Phoenix ICON wide-field infant fundus image. Camera: Phoenix ICON (100° FOV). 1240x1240px: 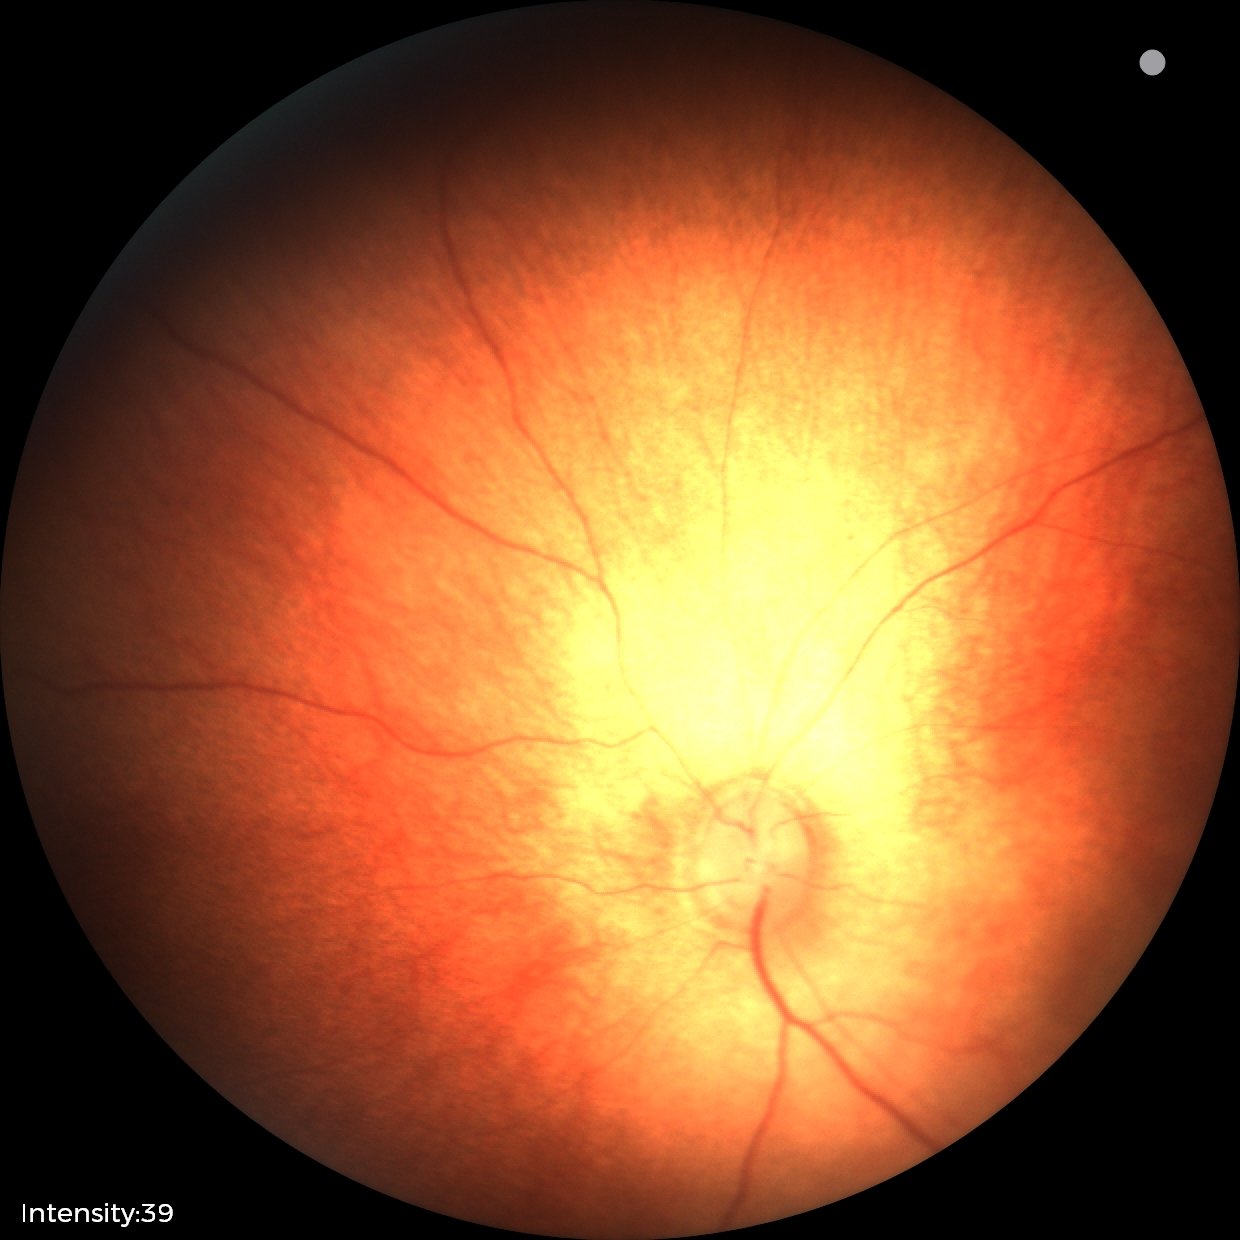 Physiological retinal appearance for postconceptual age.